848 x 848 pixels, camera: NIDEK AFC-230, no pharmacologic dilation, 45° field of view: 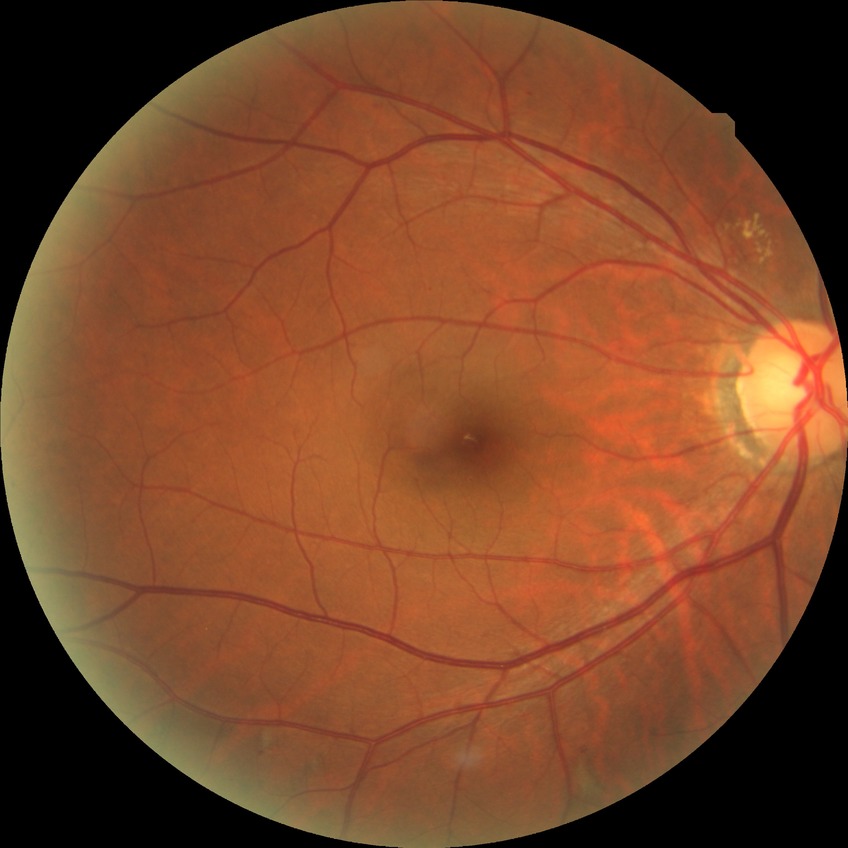 {
  "davis_grade": "SDR (simple diabetic retinopathy)"
}